45-degree field of view.
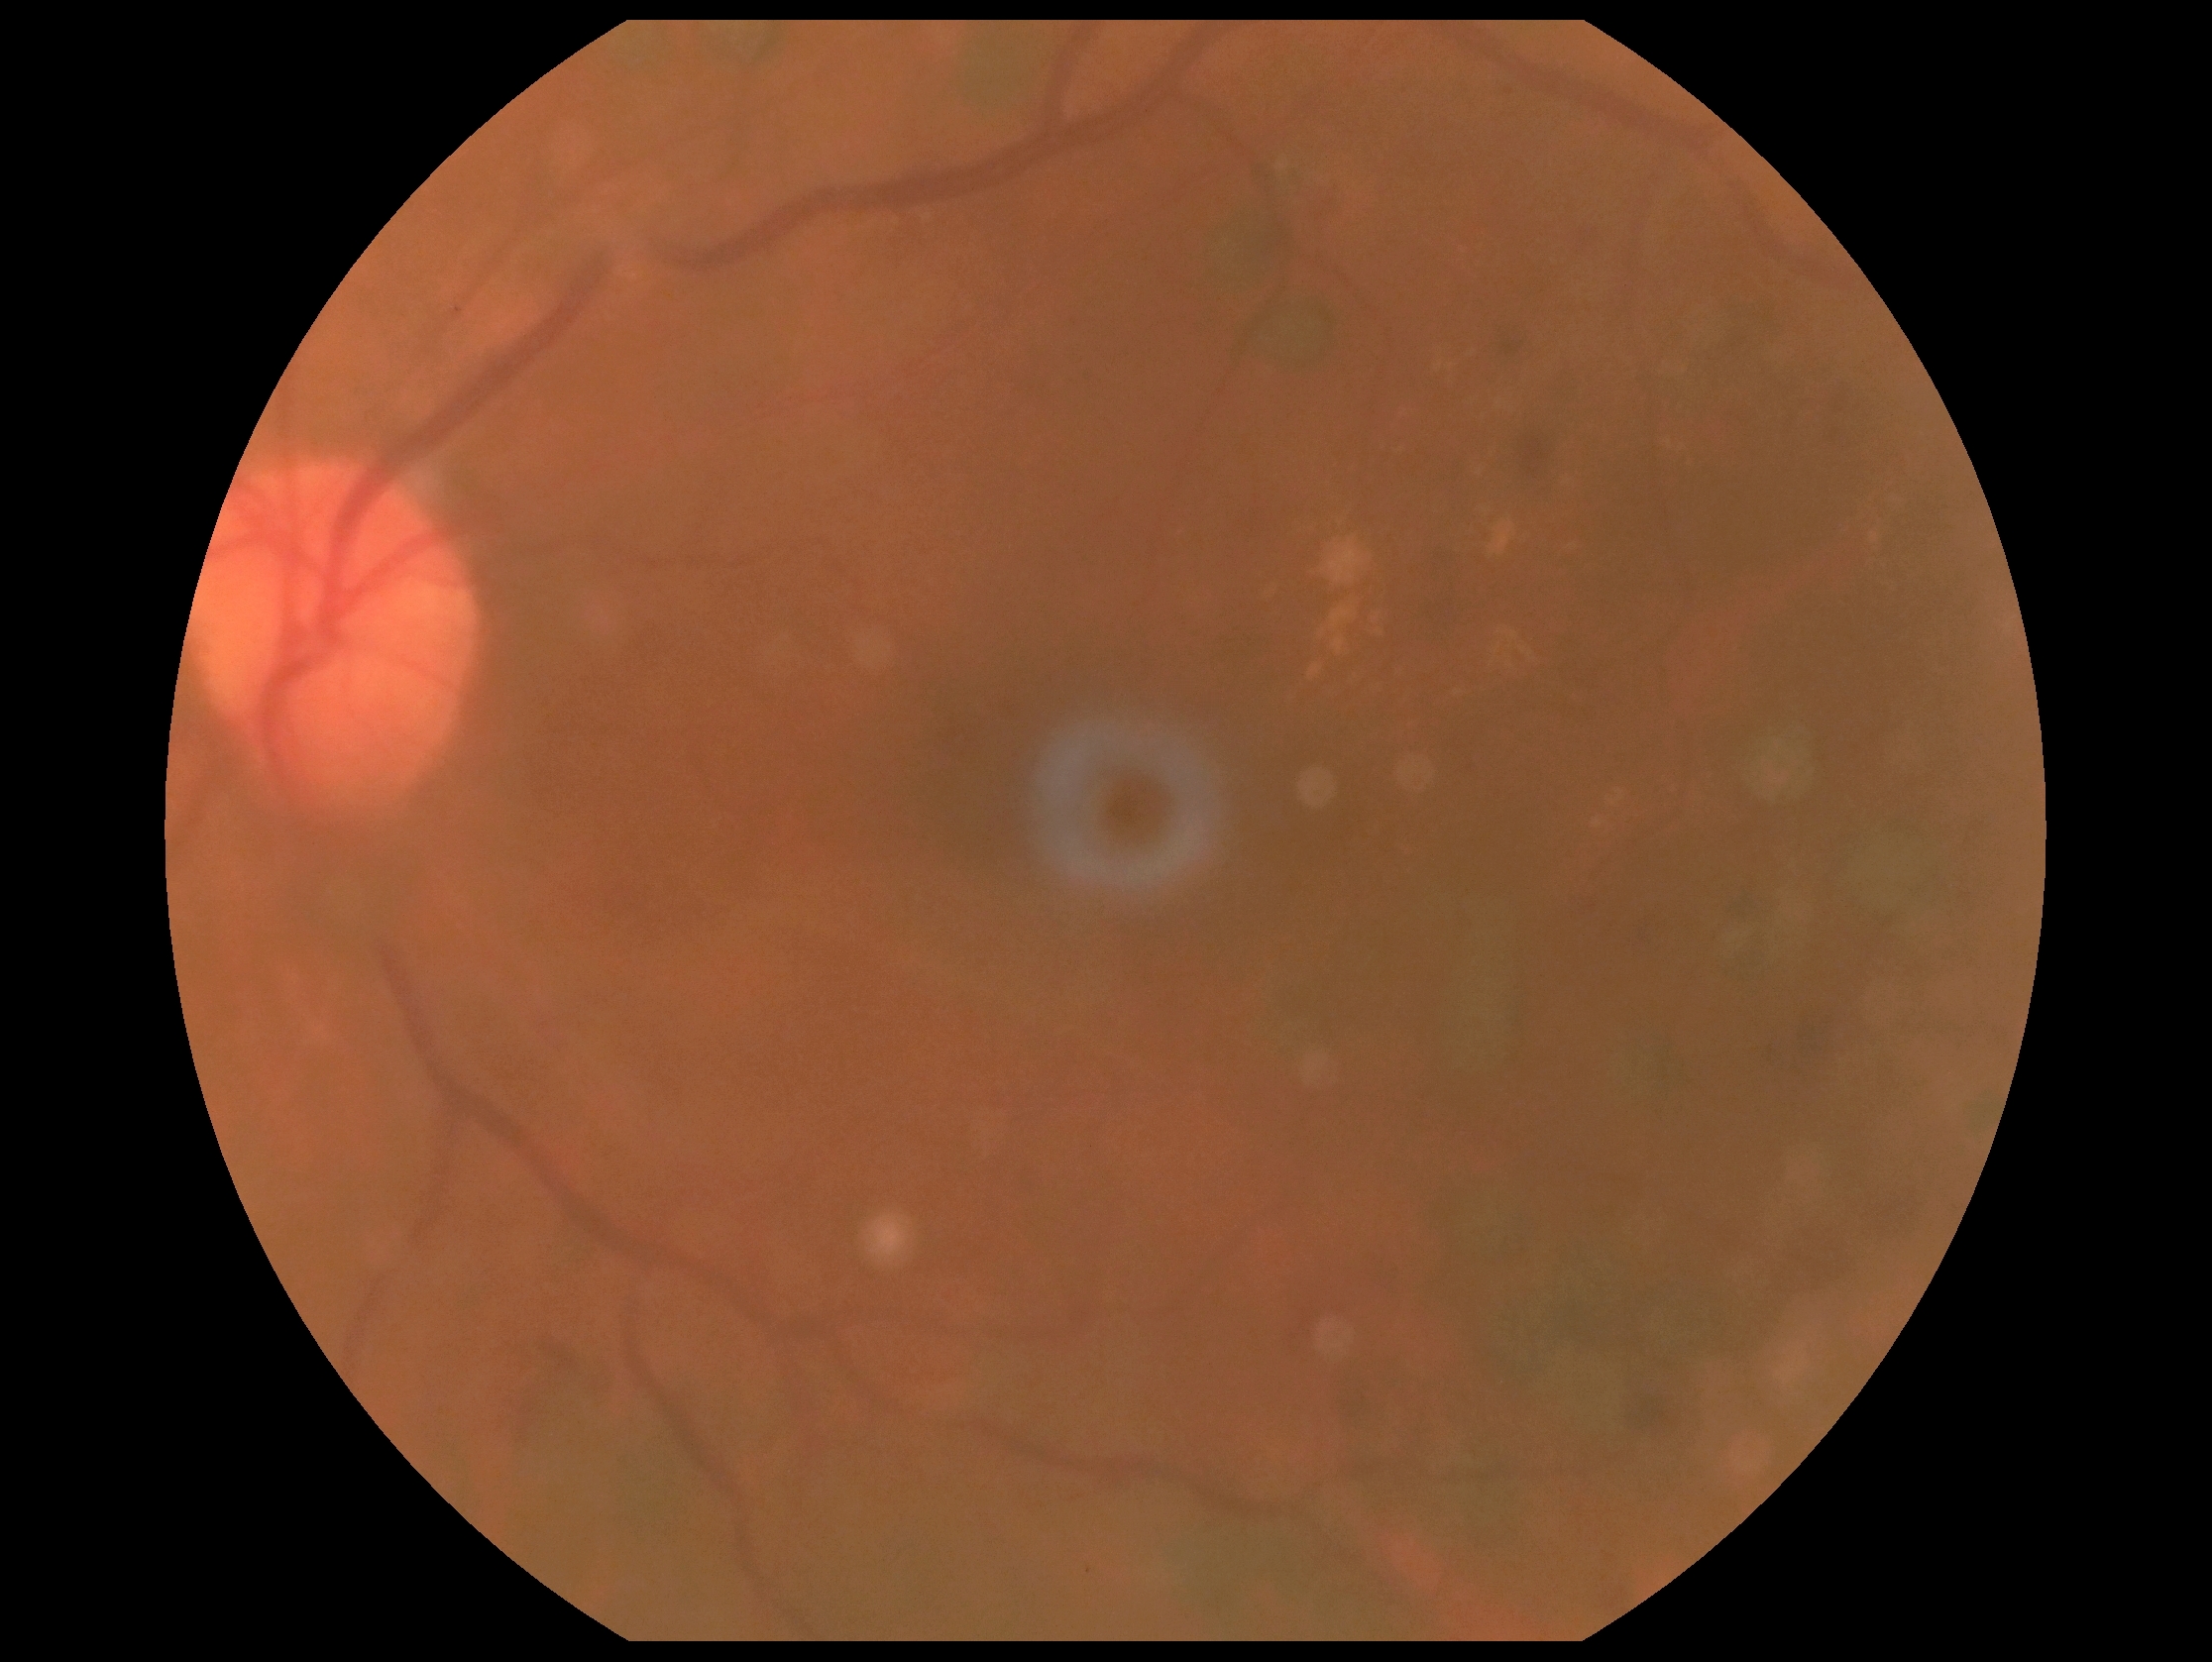

DR grade is 2 — more than just microaneurysms but less than severe NPDR.